CFP.
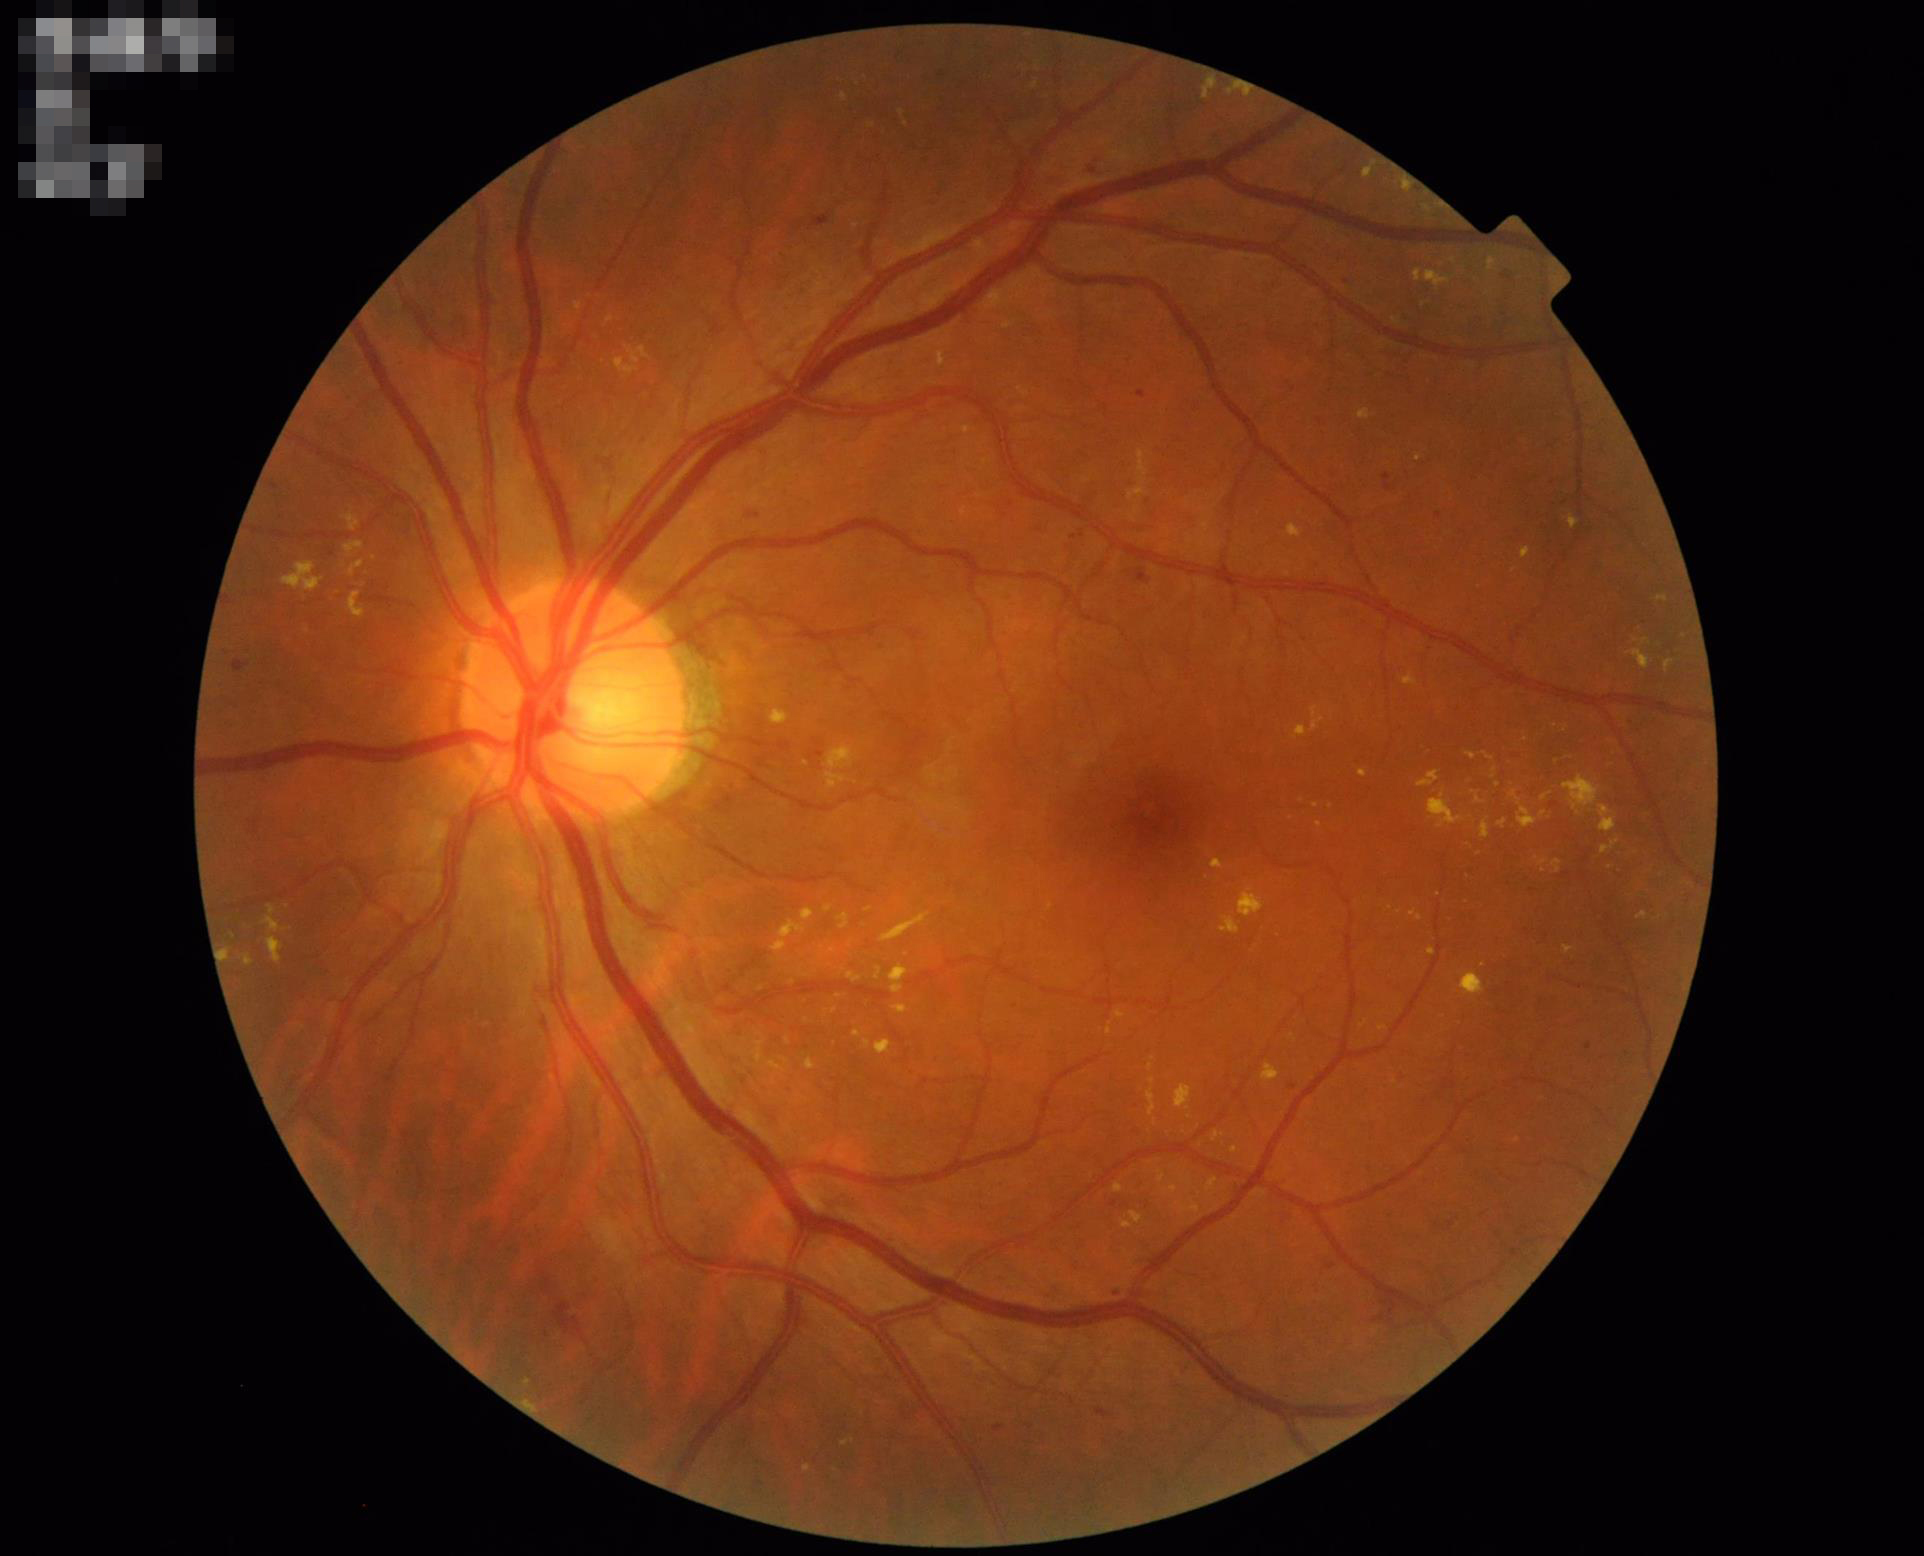 Vessels and details are readily distinguishable. Image is sharp throughout the field. Overall image quality is good.